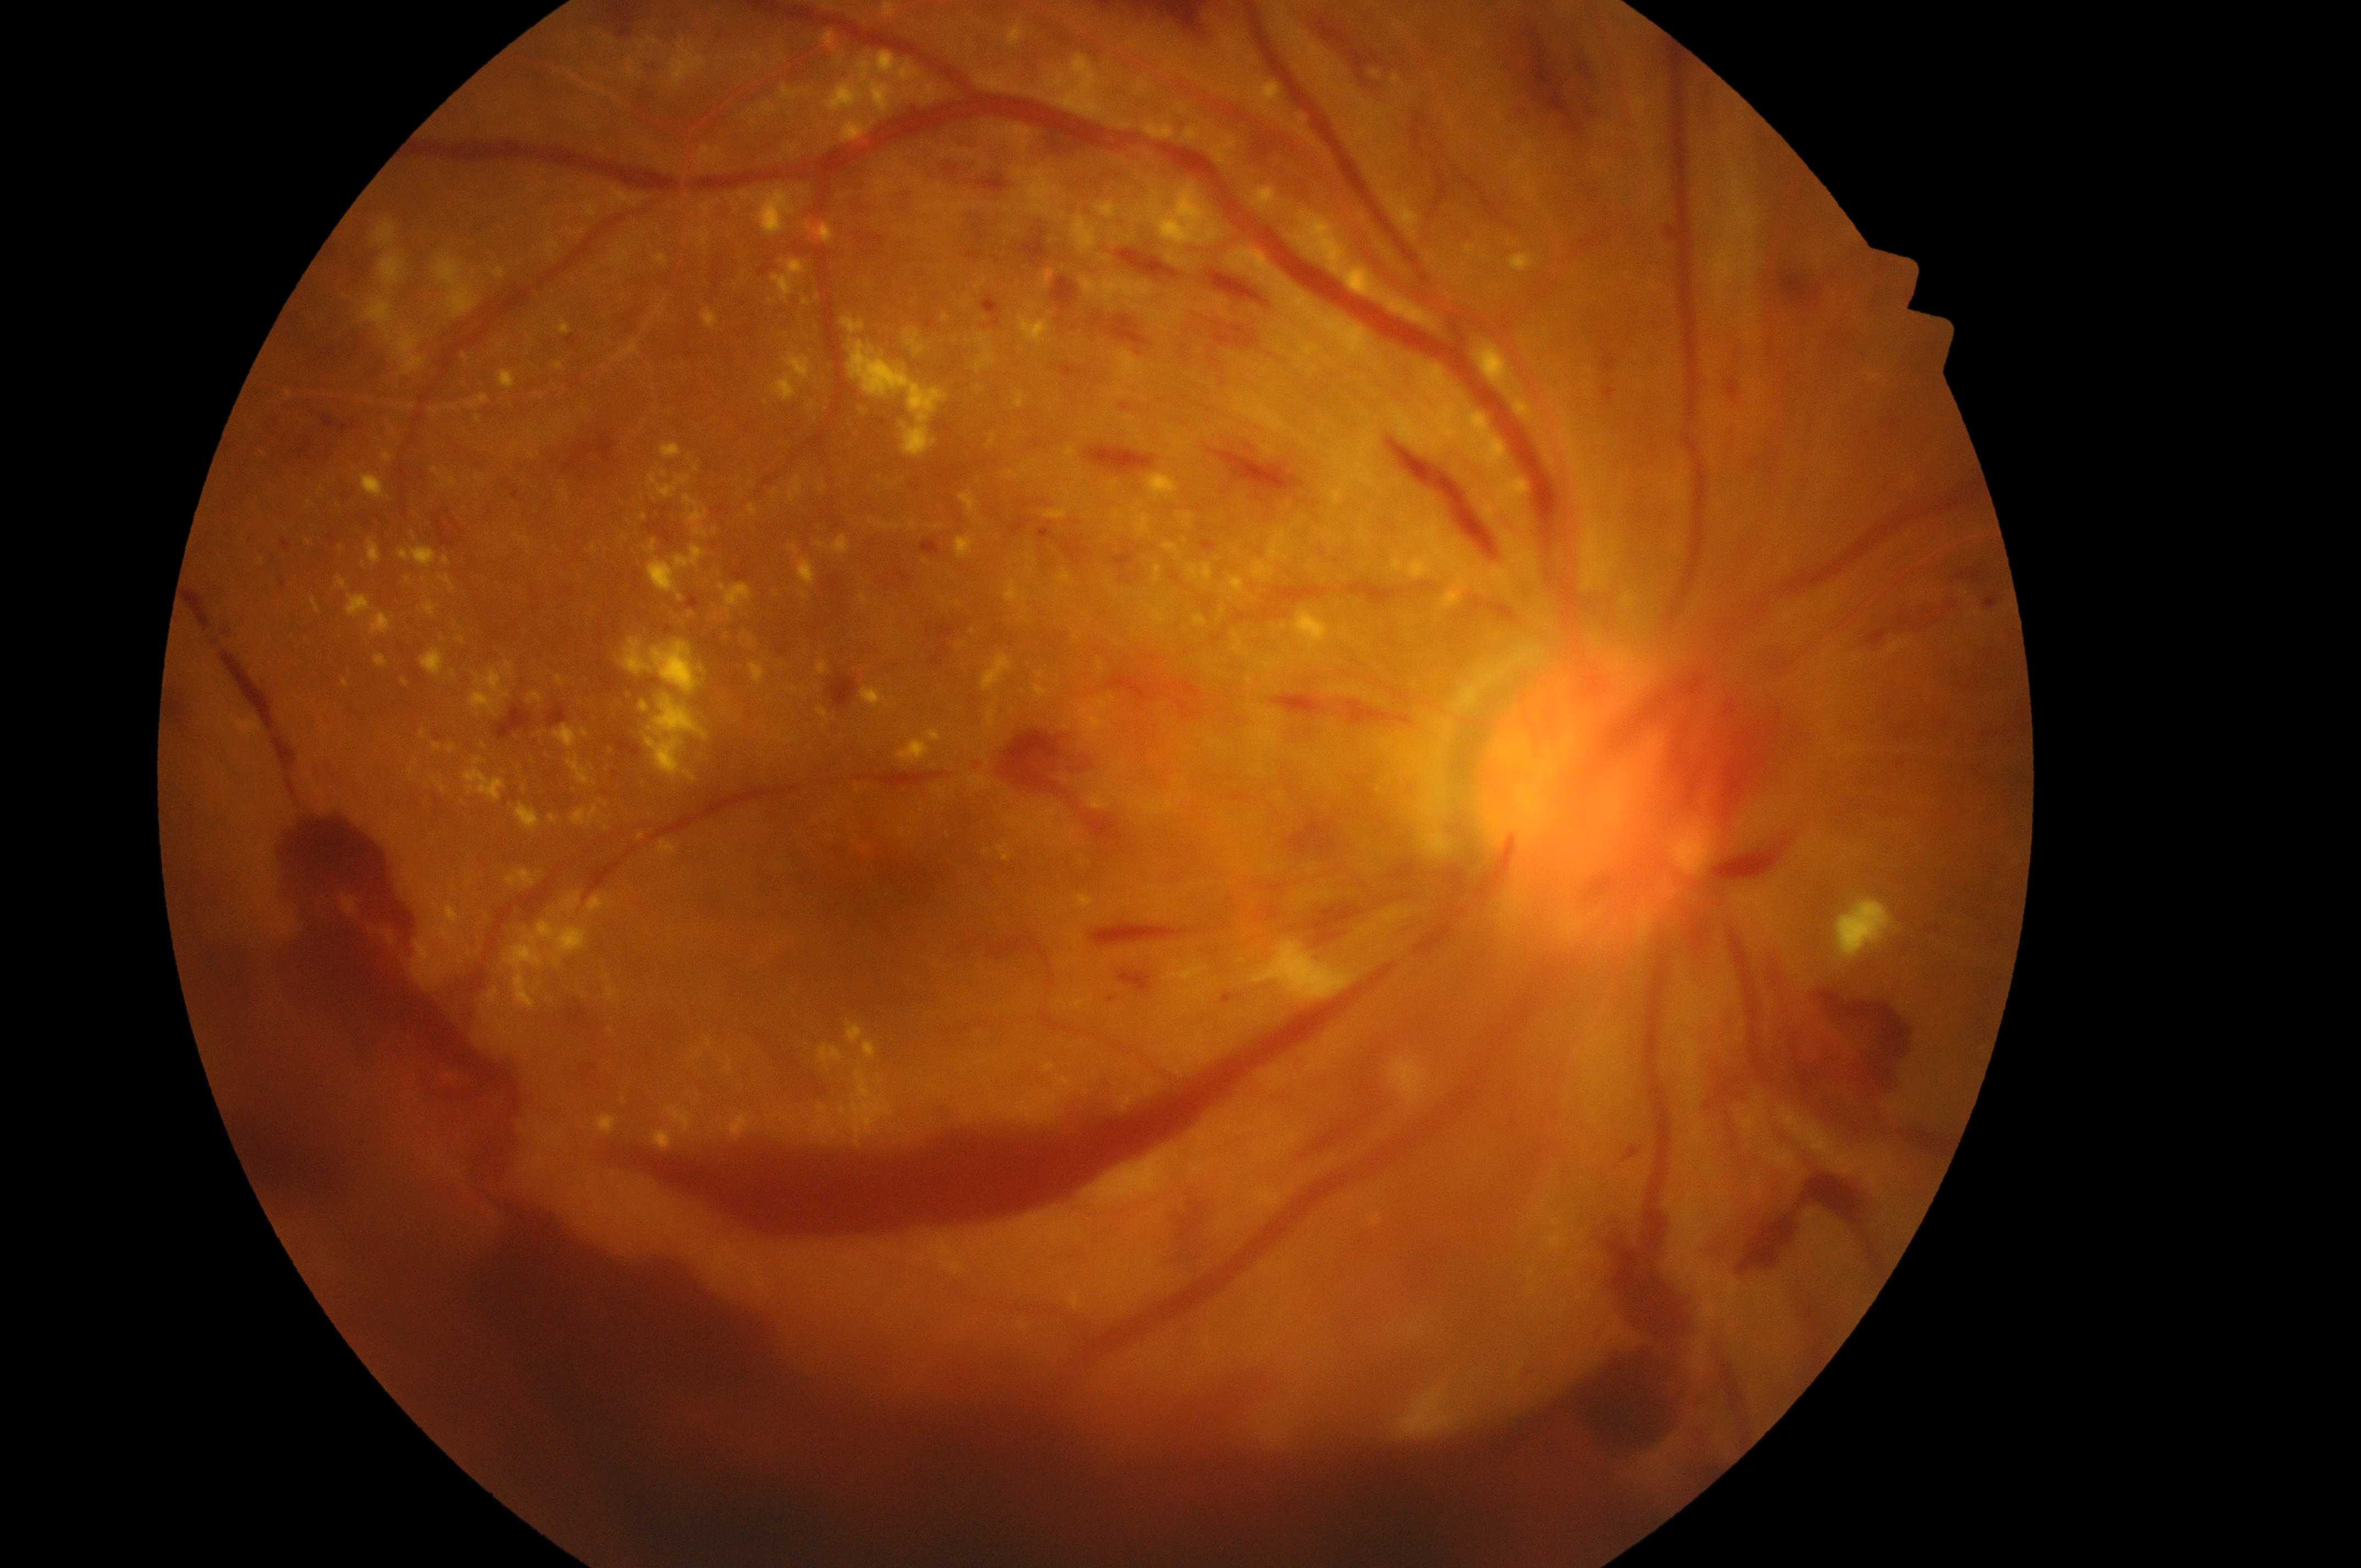
diabetic retinopathy grade: 4 (PDR) | oculus dexter | foveal center: (x=910, y=886) | macular edema risk: grade 2 (high risk) | the optic disc: (x=1580, y=800).